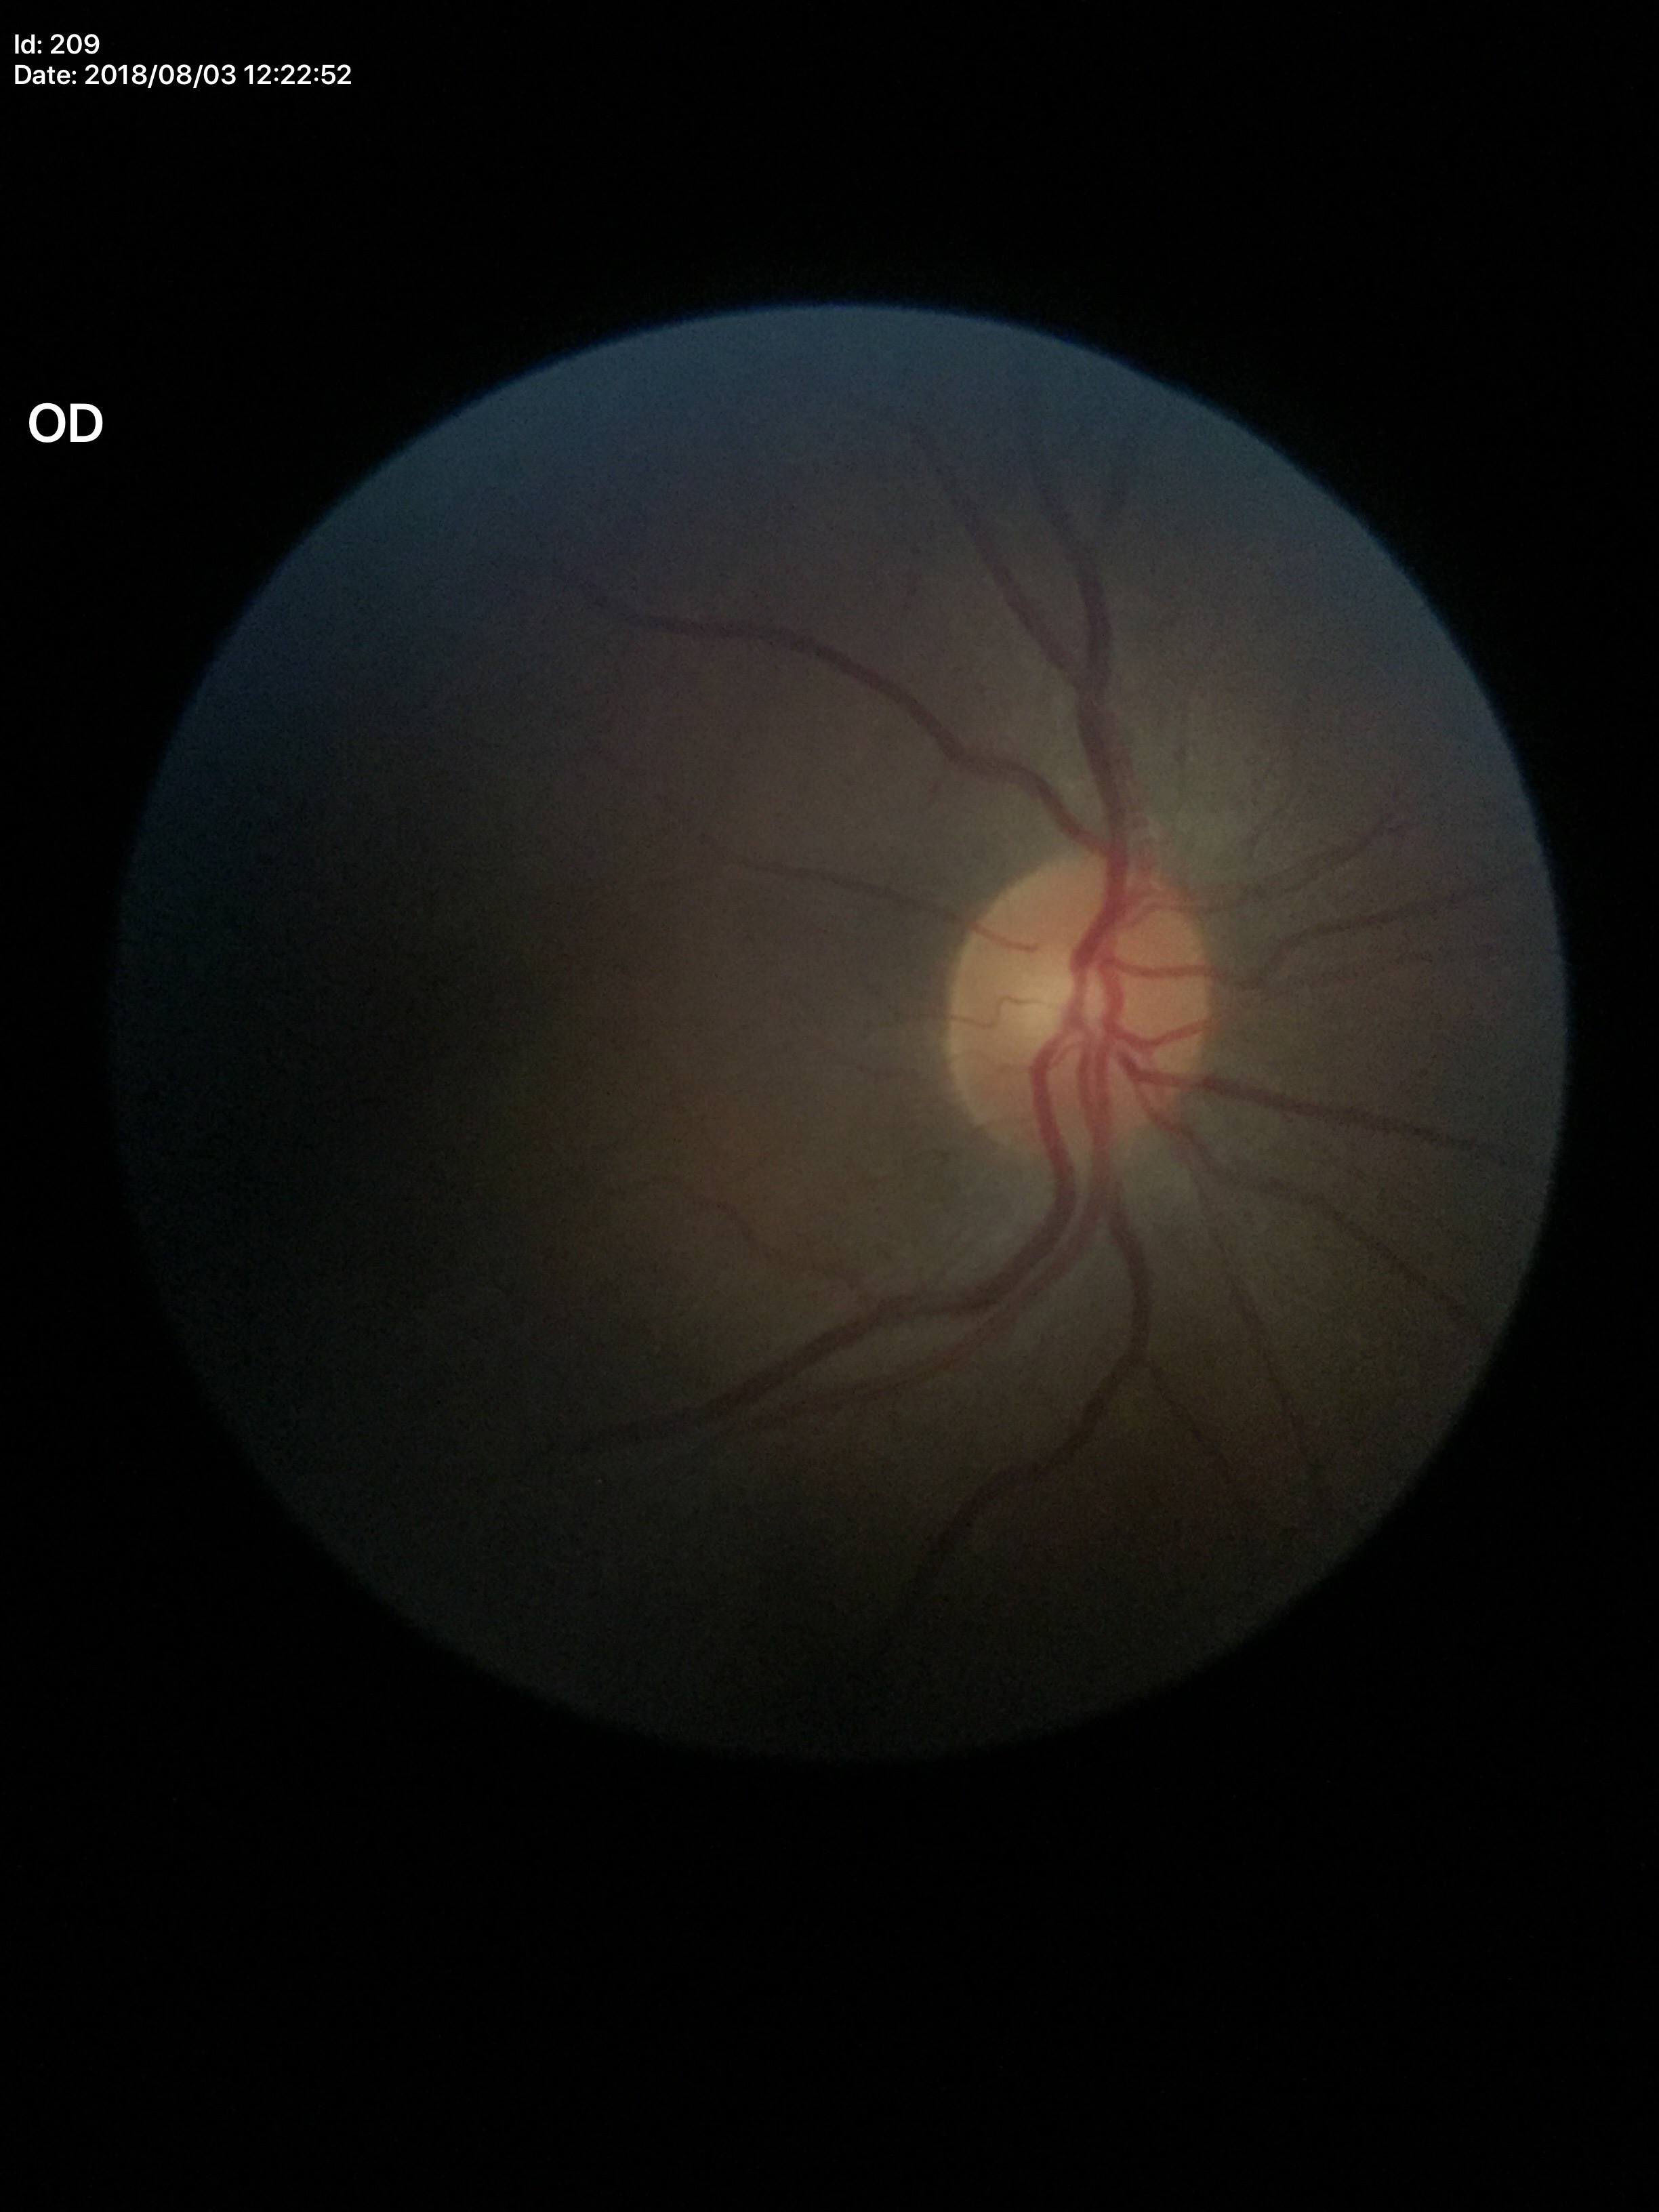 Glaucoma evaluation: no suspicious findings (all 5 graders called normal). Vertical CDR (VCDR) of 0.43.